30° FOV — 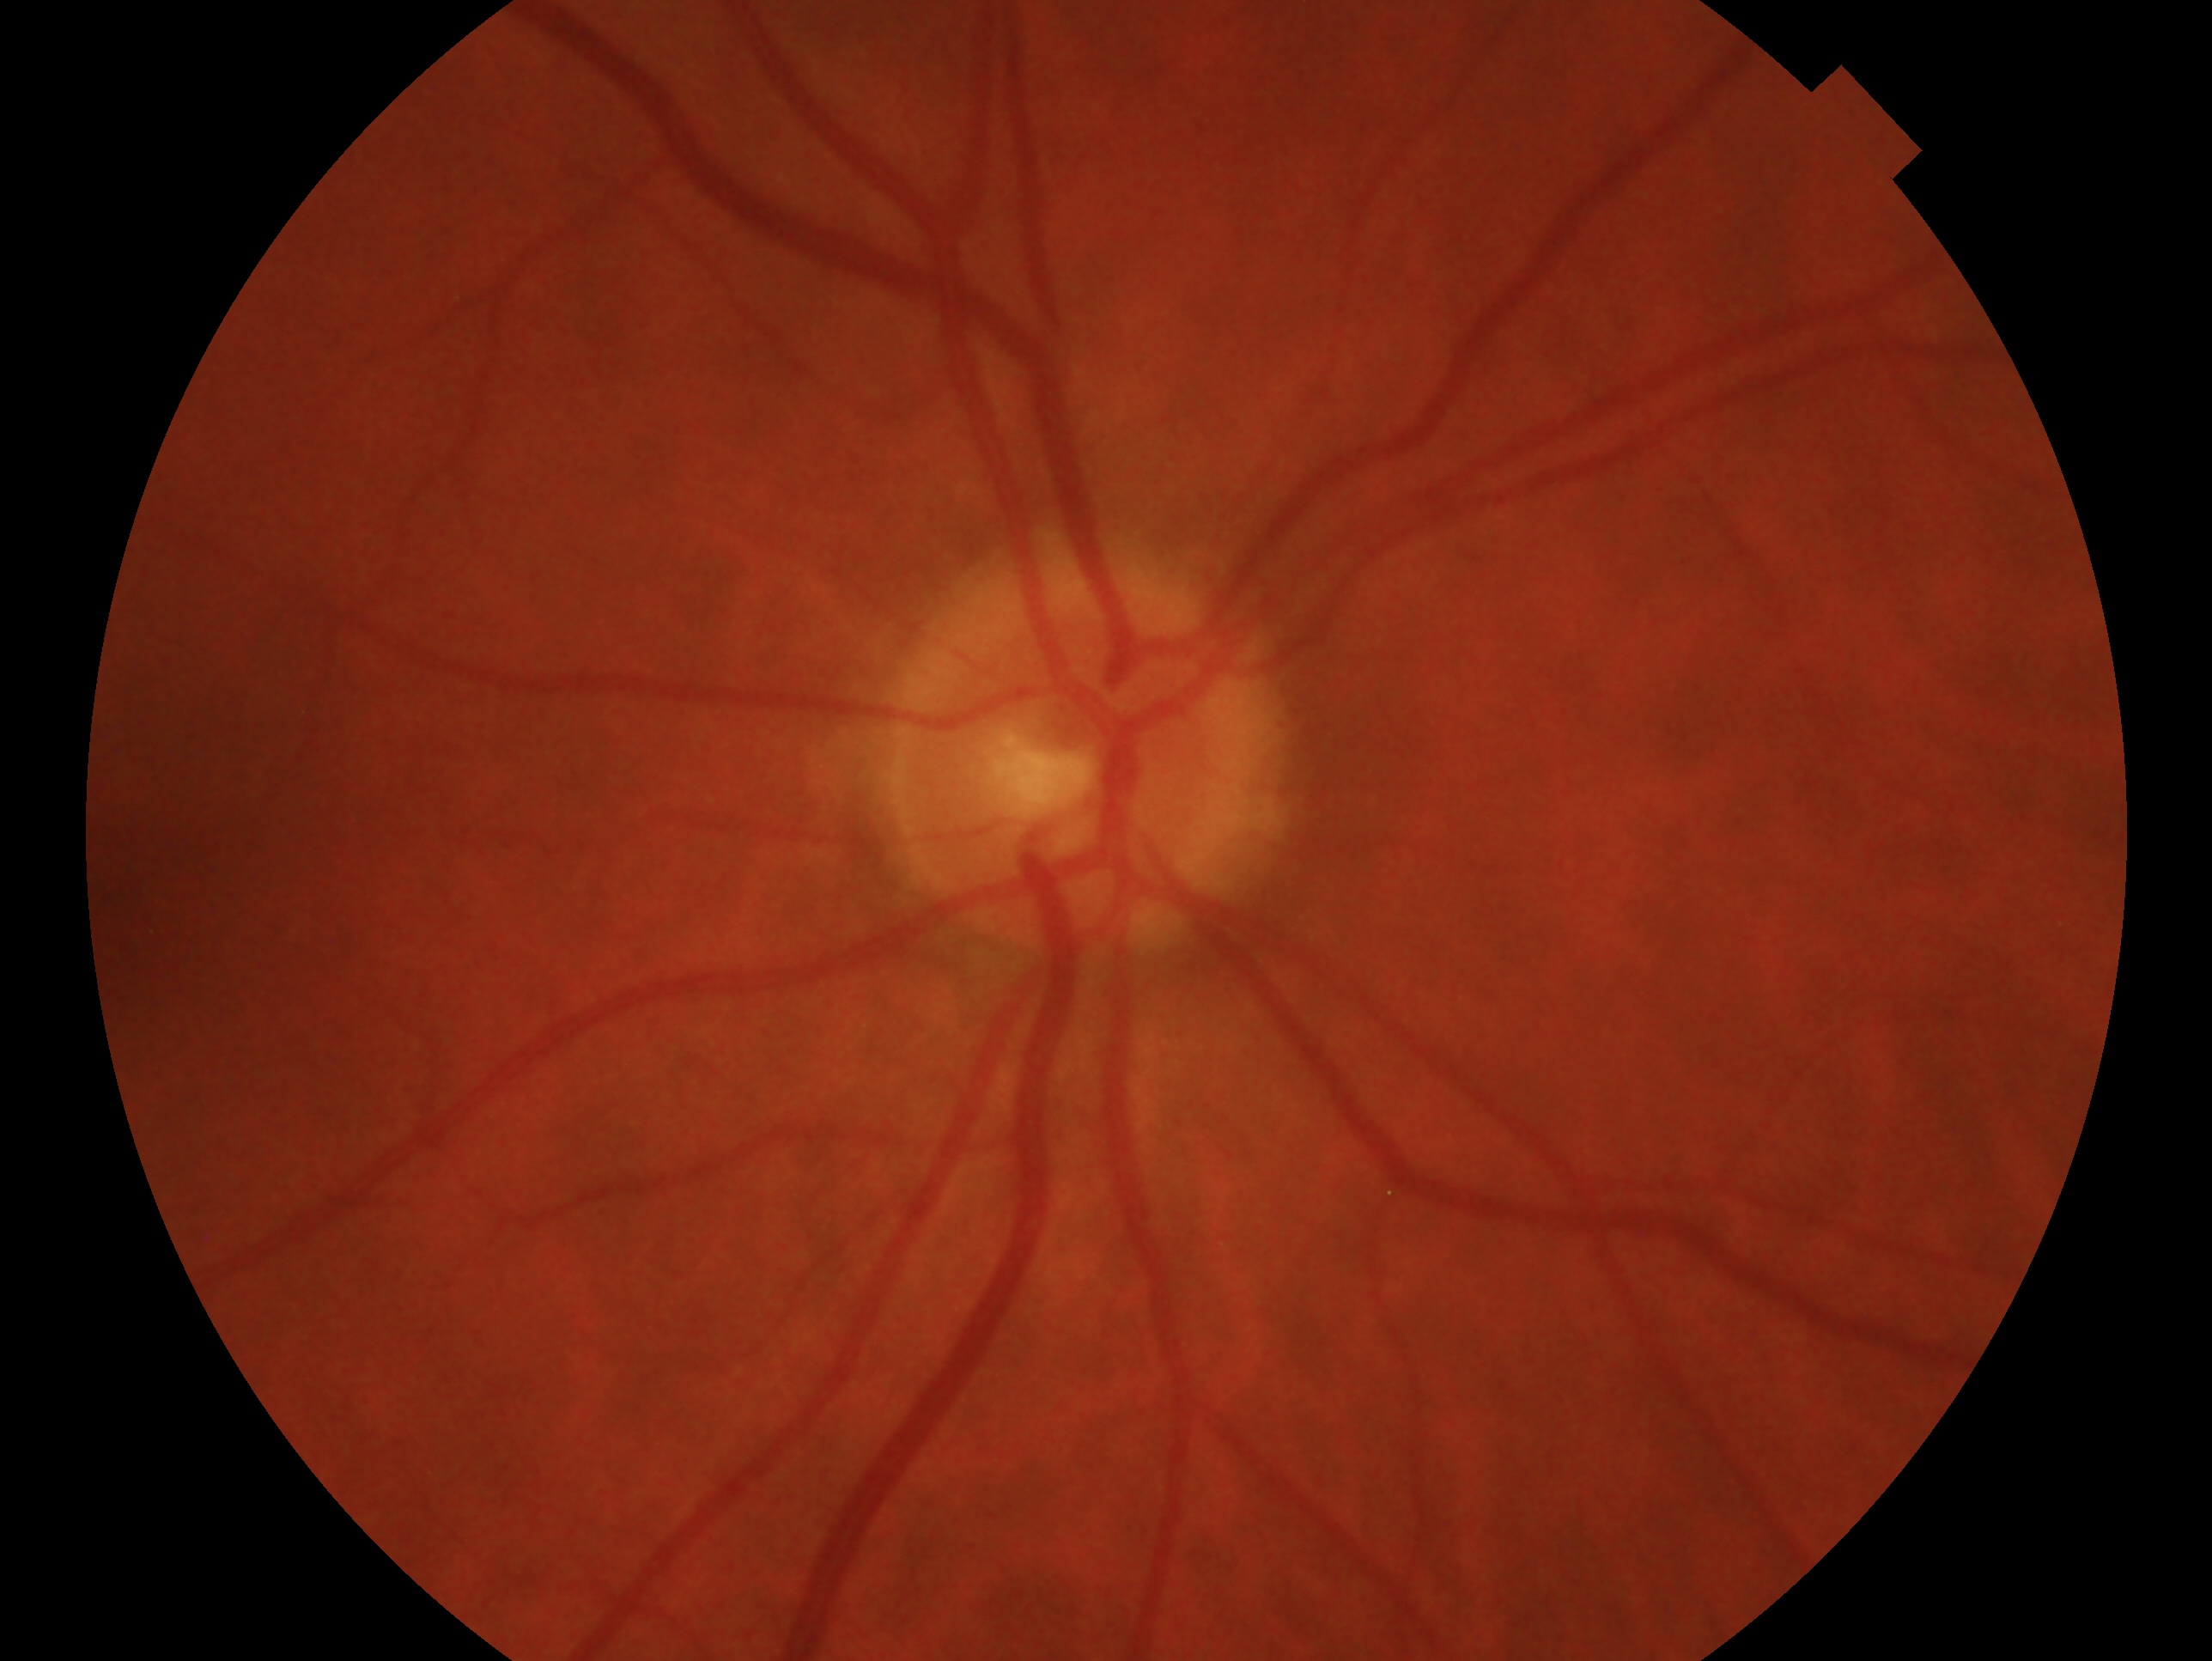

Glaucoma diagnosis — negative for glaucoma. This is the OD.